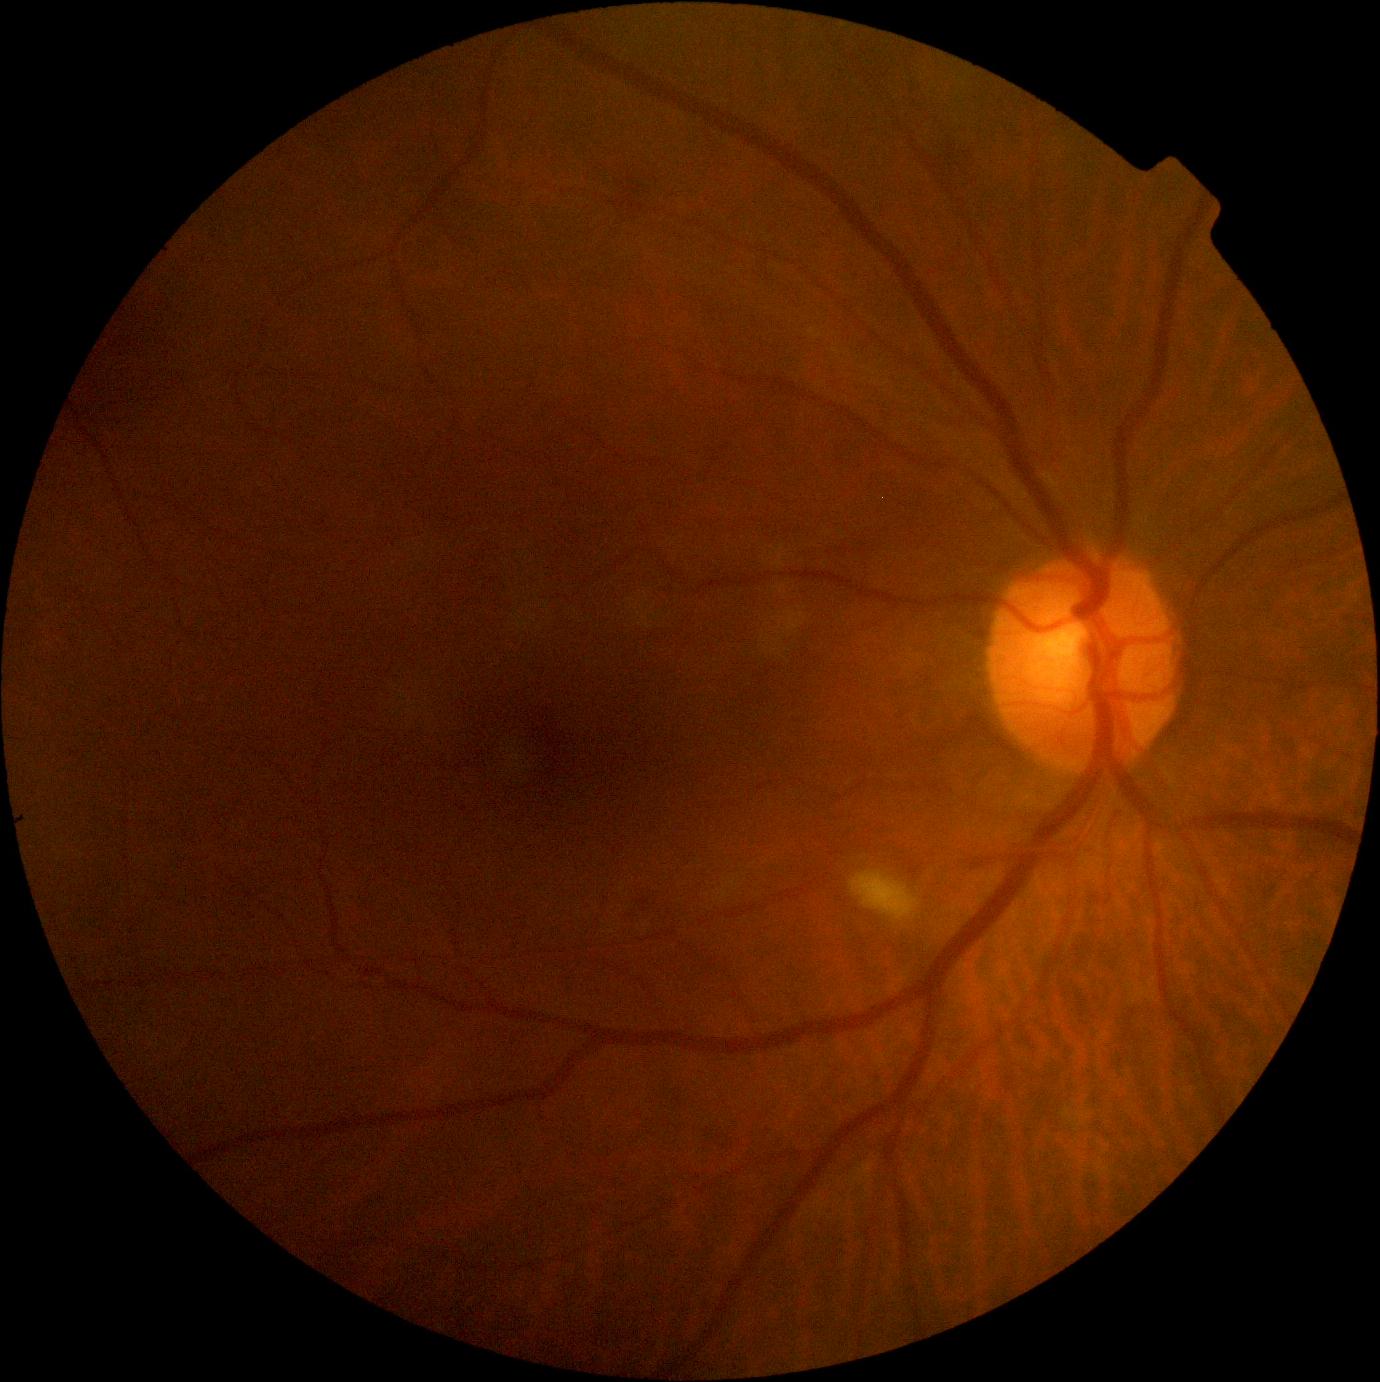
DR is grade 2 (moderate NPDR).